Cropped from a 35-degree field of view · optic disc region of a color fundus photo:
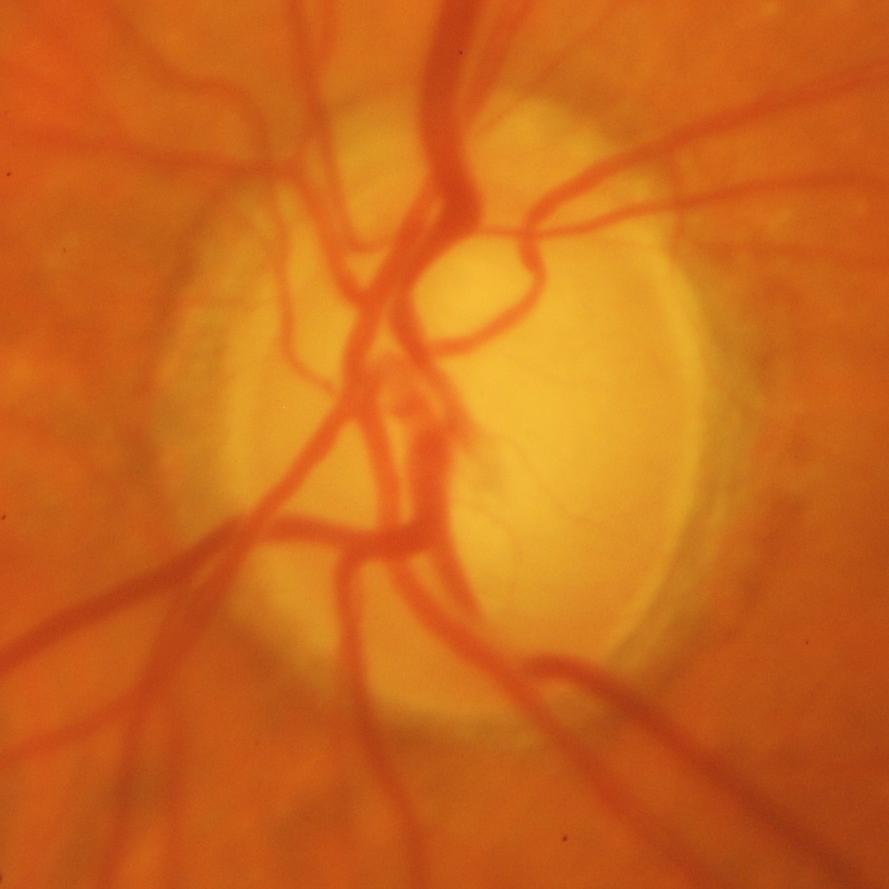
There is evidence of glaucoma.